Phoenix ICON wide-field infant fundus image — 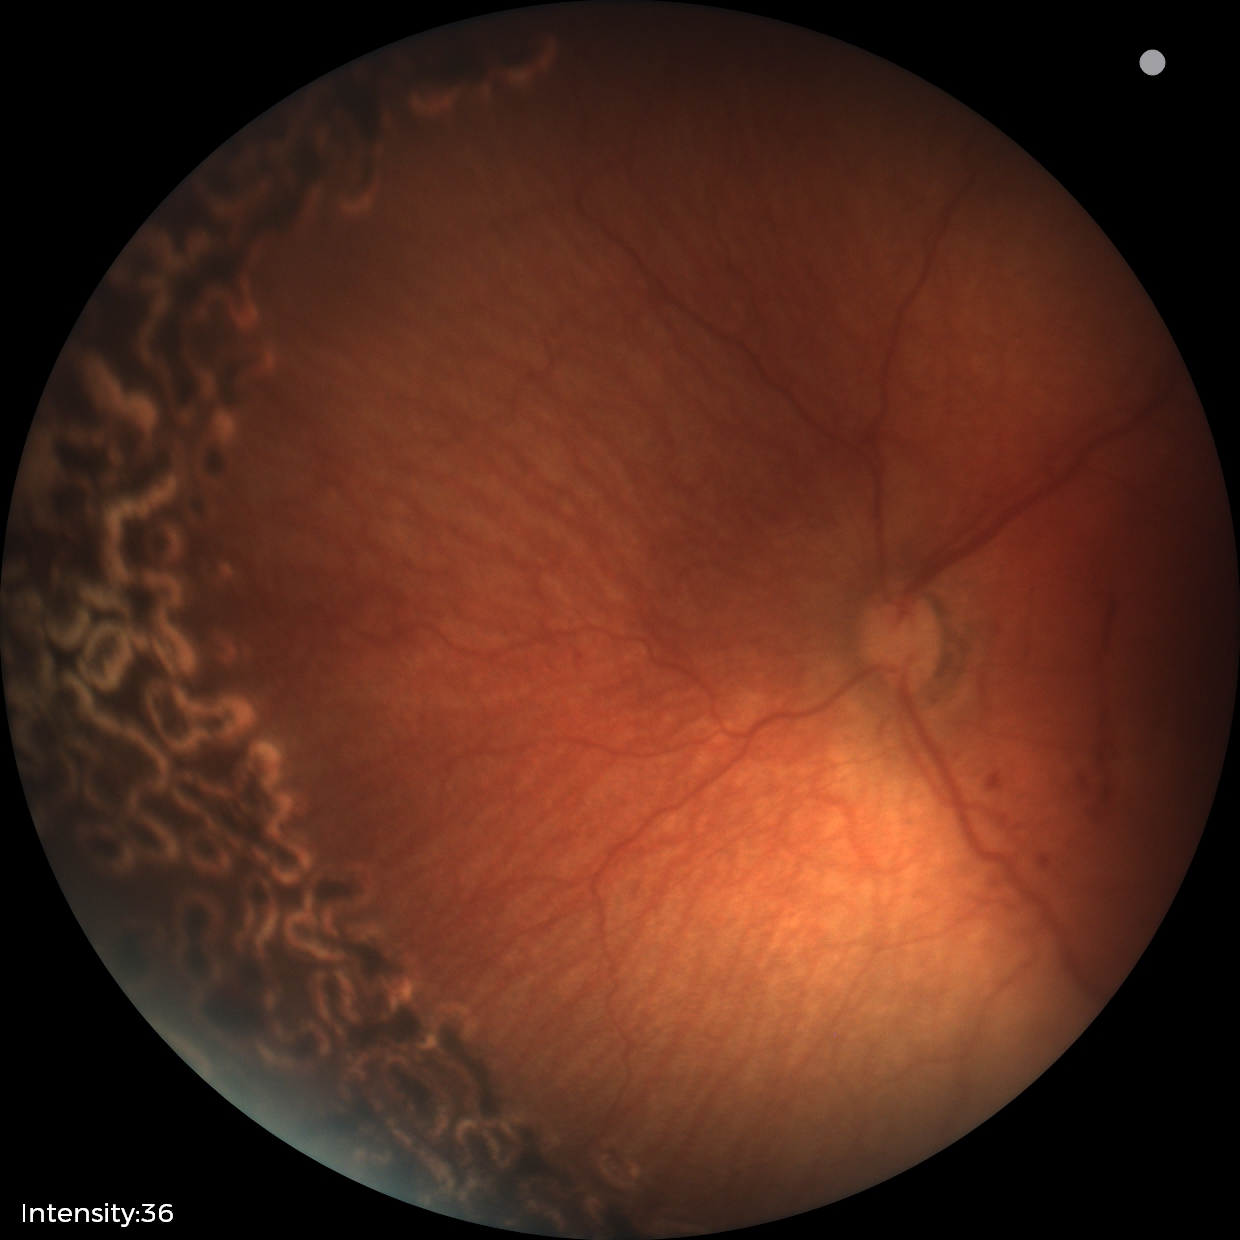
Plus disease absent. Examination diagnosed as status post retinopathy of prematurity — retinal appearance after treated retinopathy of prematurity.